Infant wide-field retinal image — 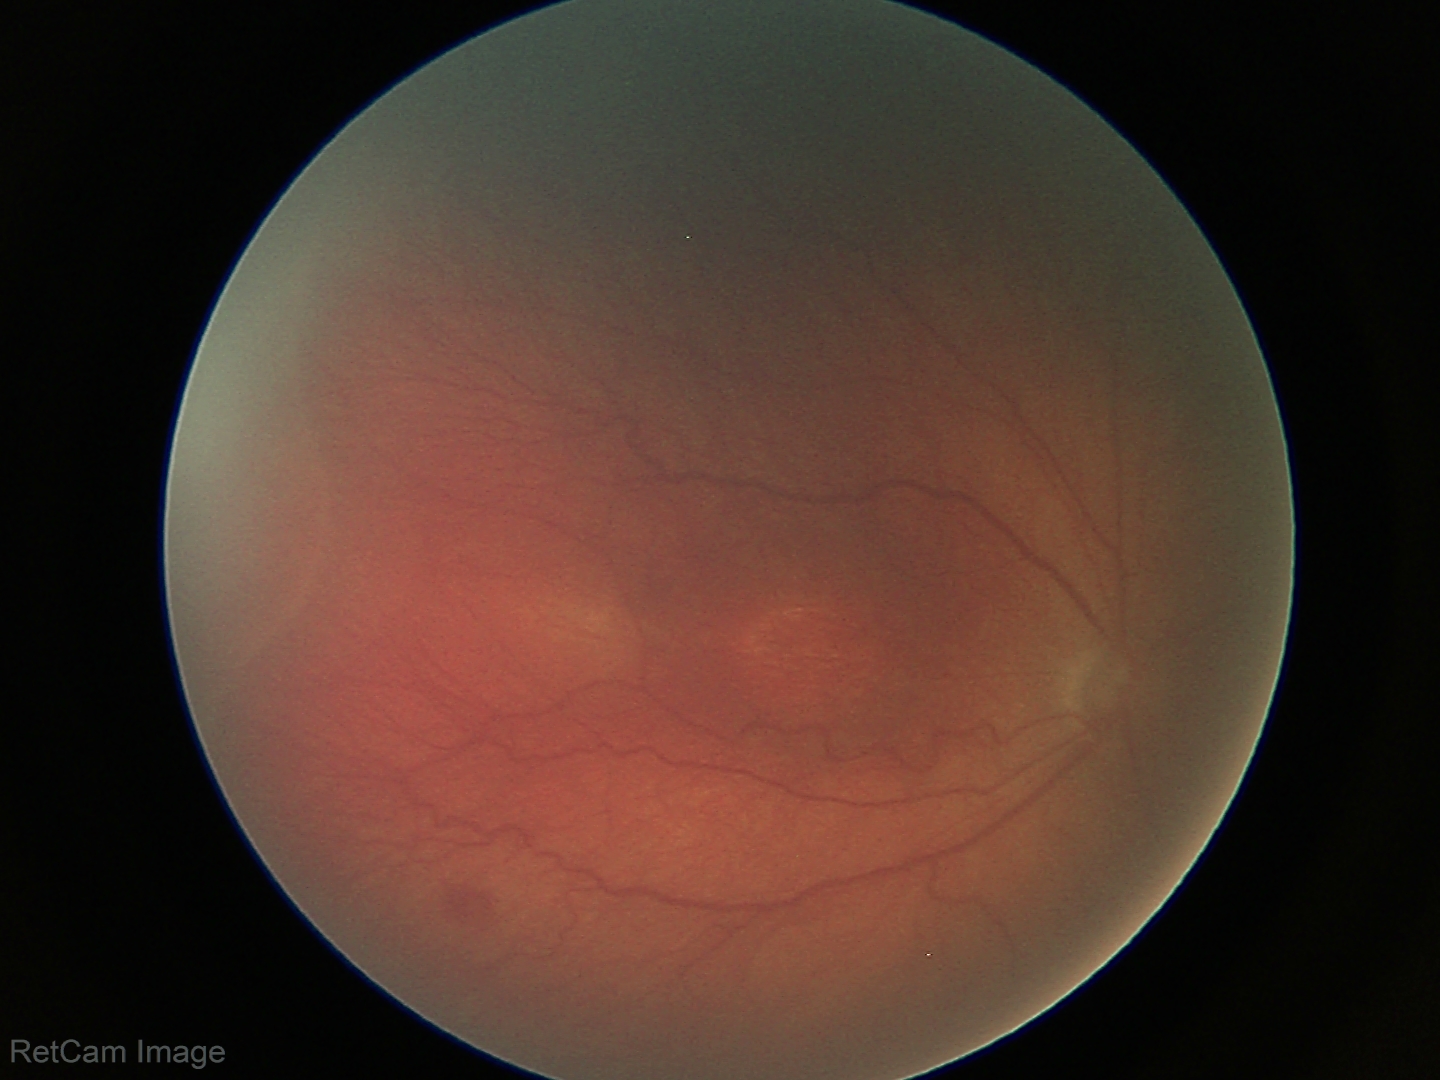

Series diagnosed as ROP stage 3.